Color fundus photograph. Image size 1920x1440:
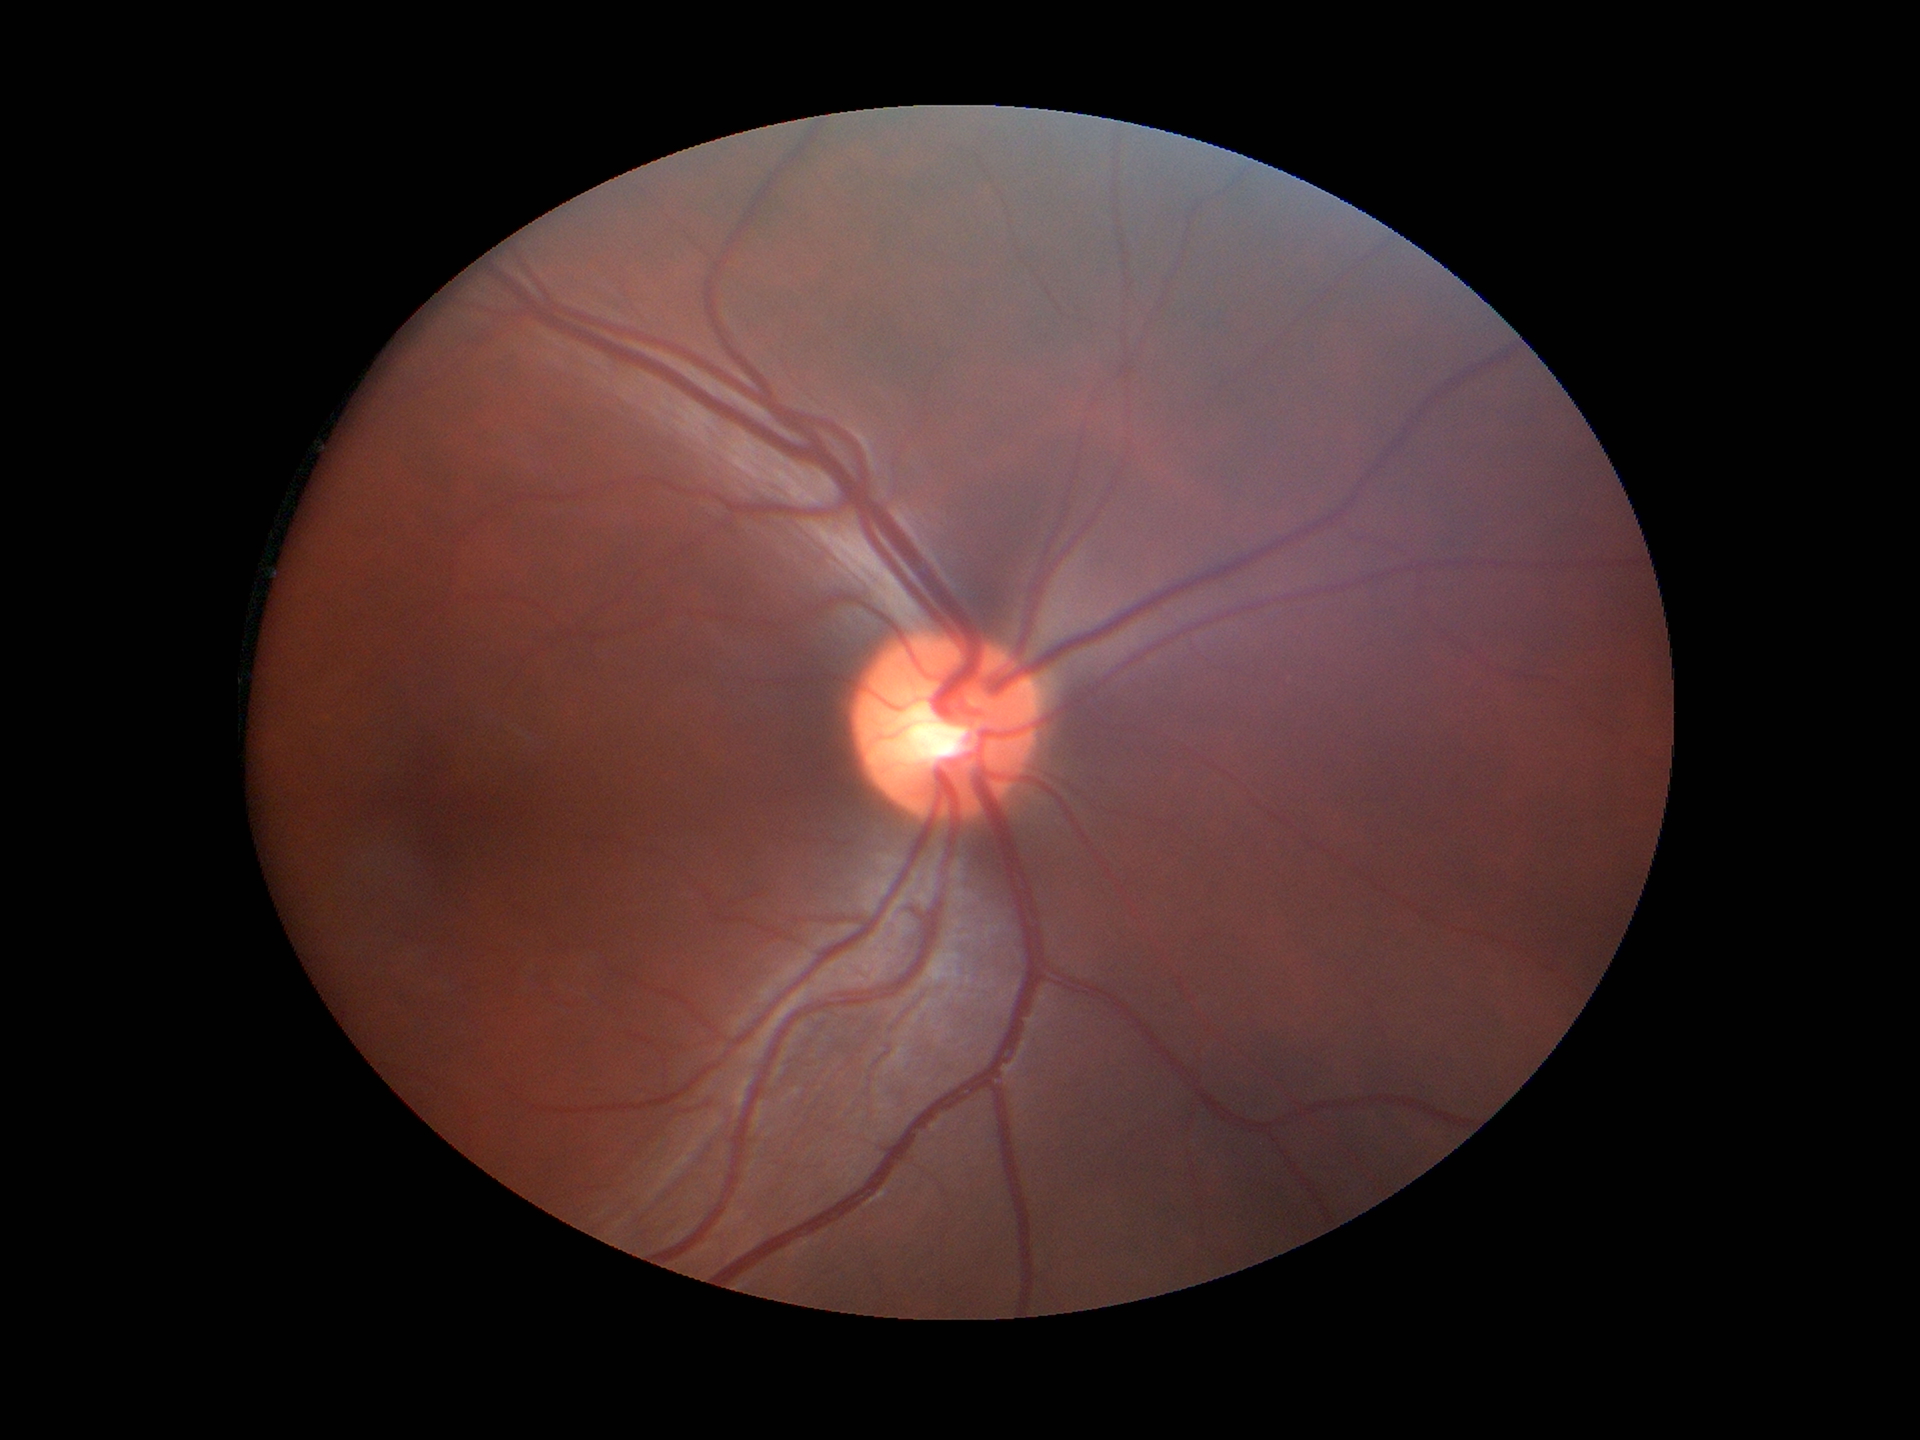

Glaucoma decision: no suspicious findings. Vertical cup-to-disc ratio is 0.48.